45° FOV.
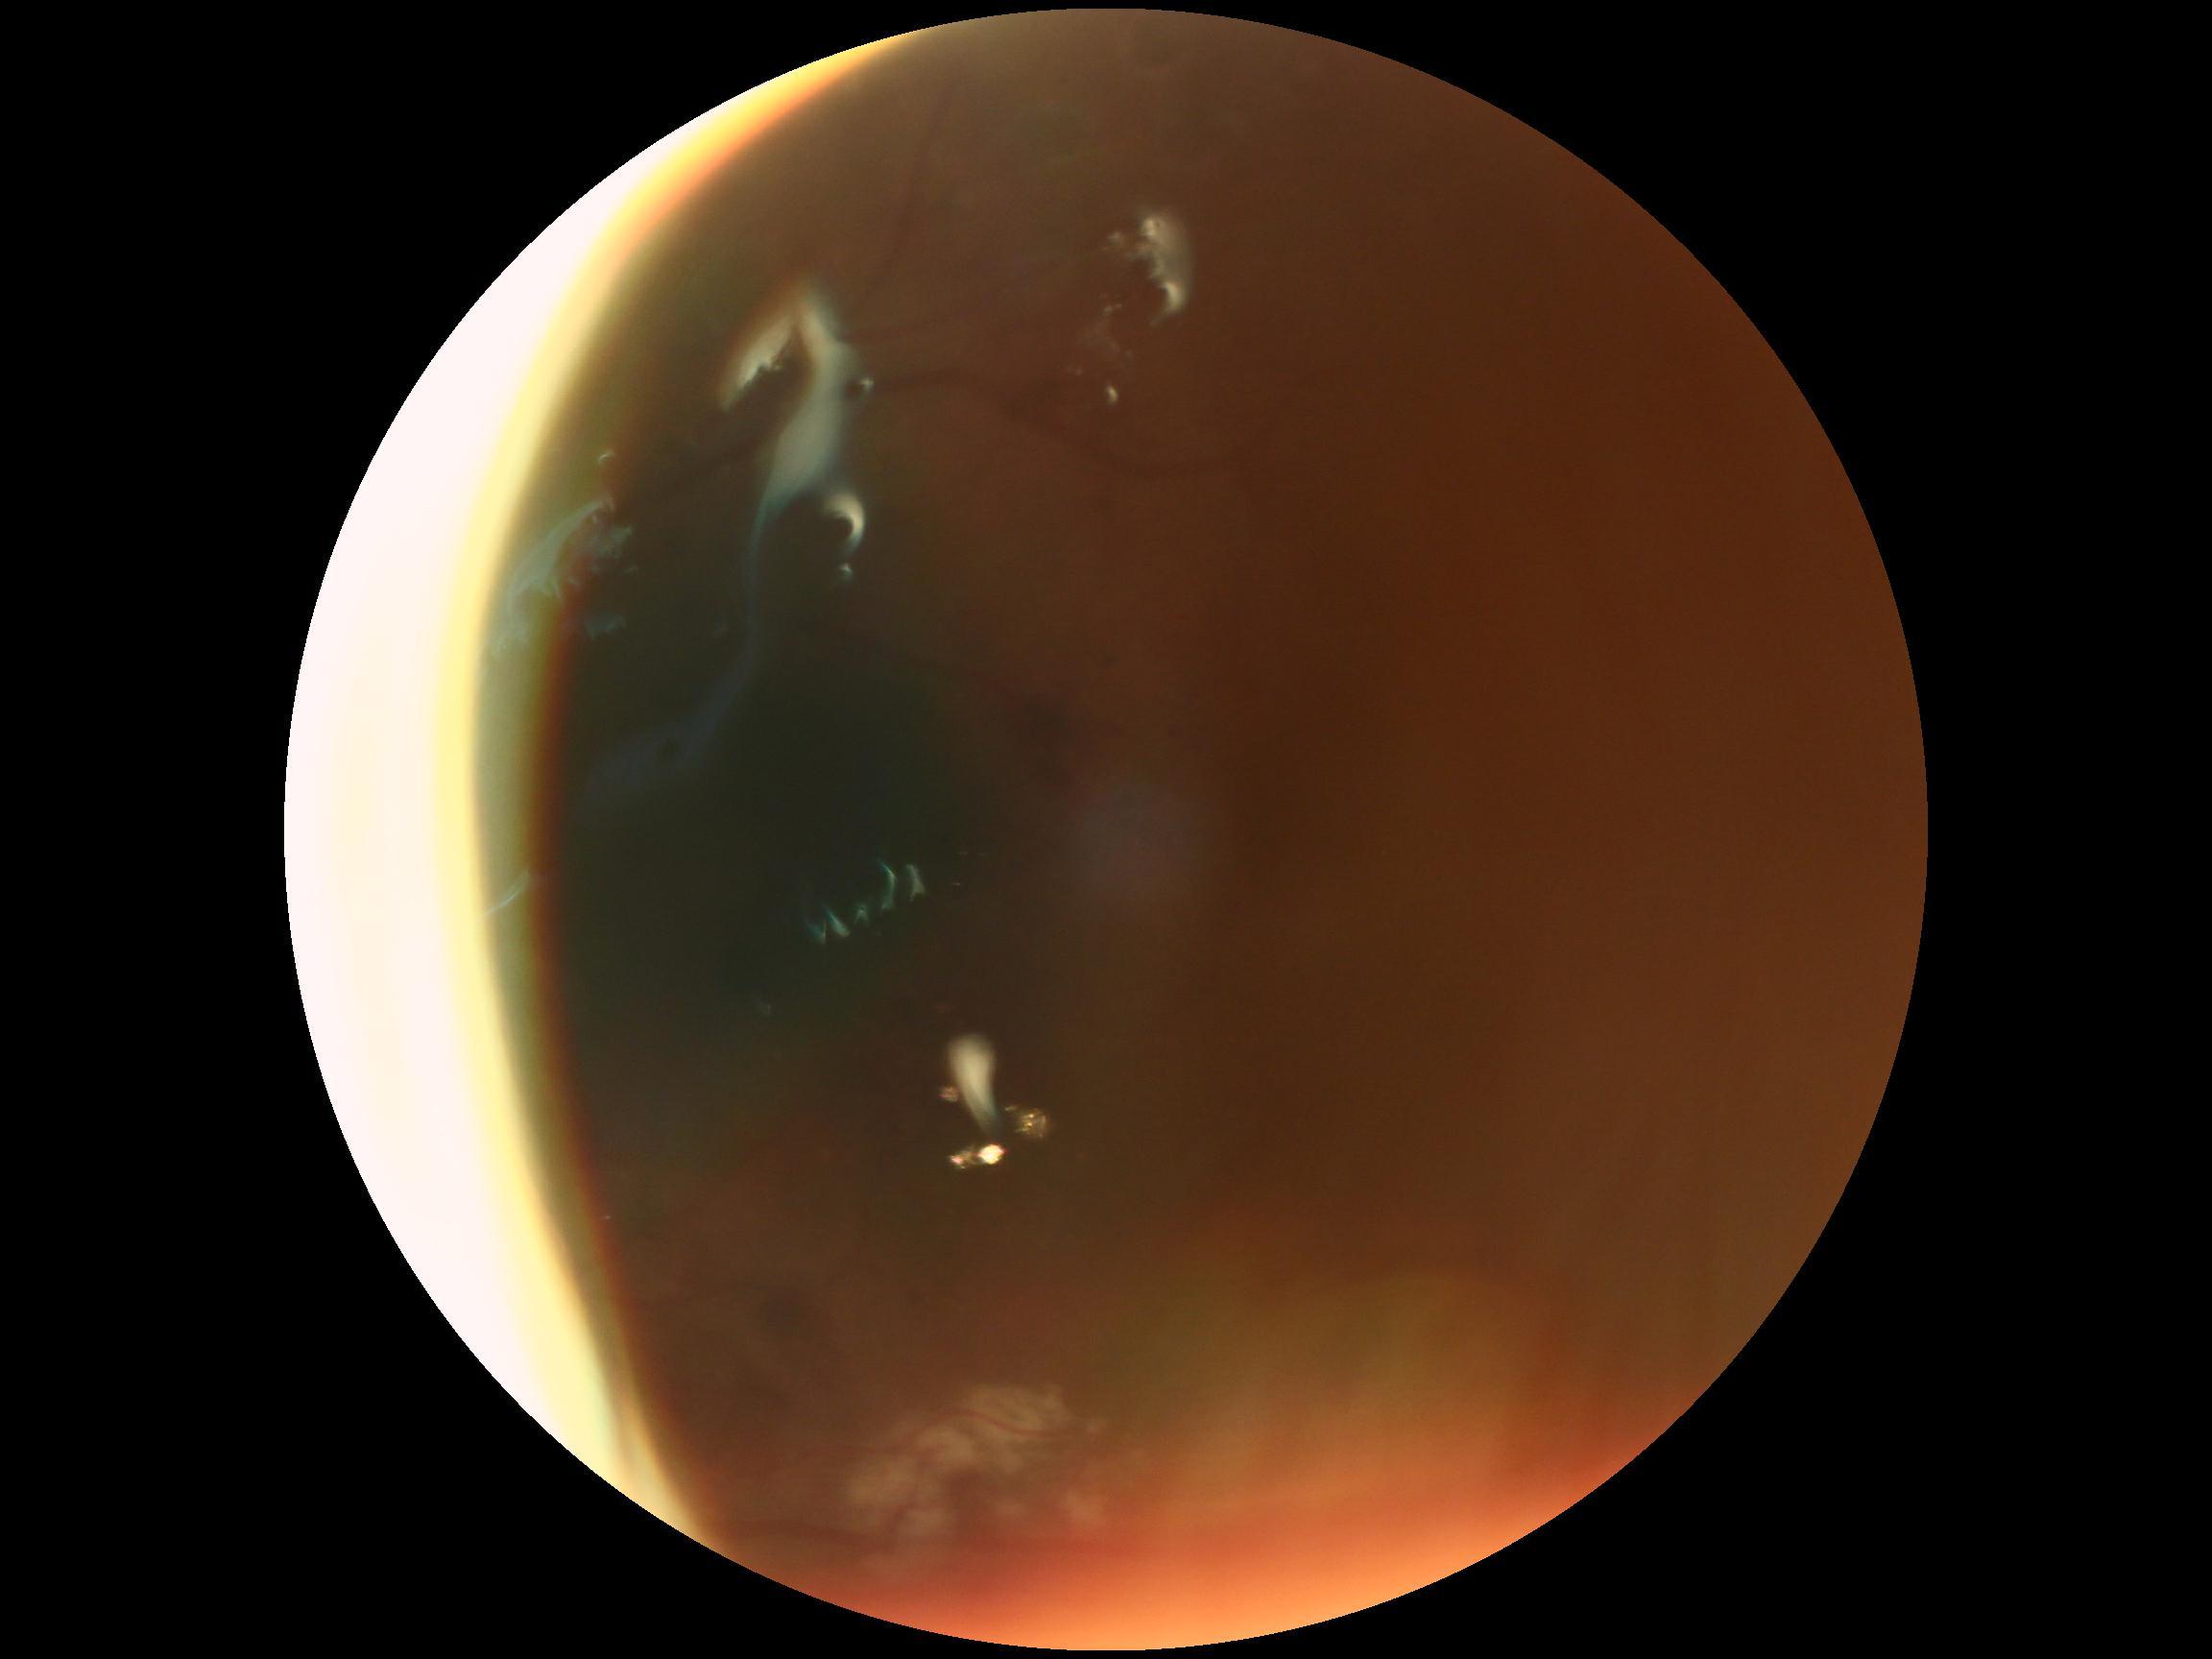
DR severity@ungradable.